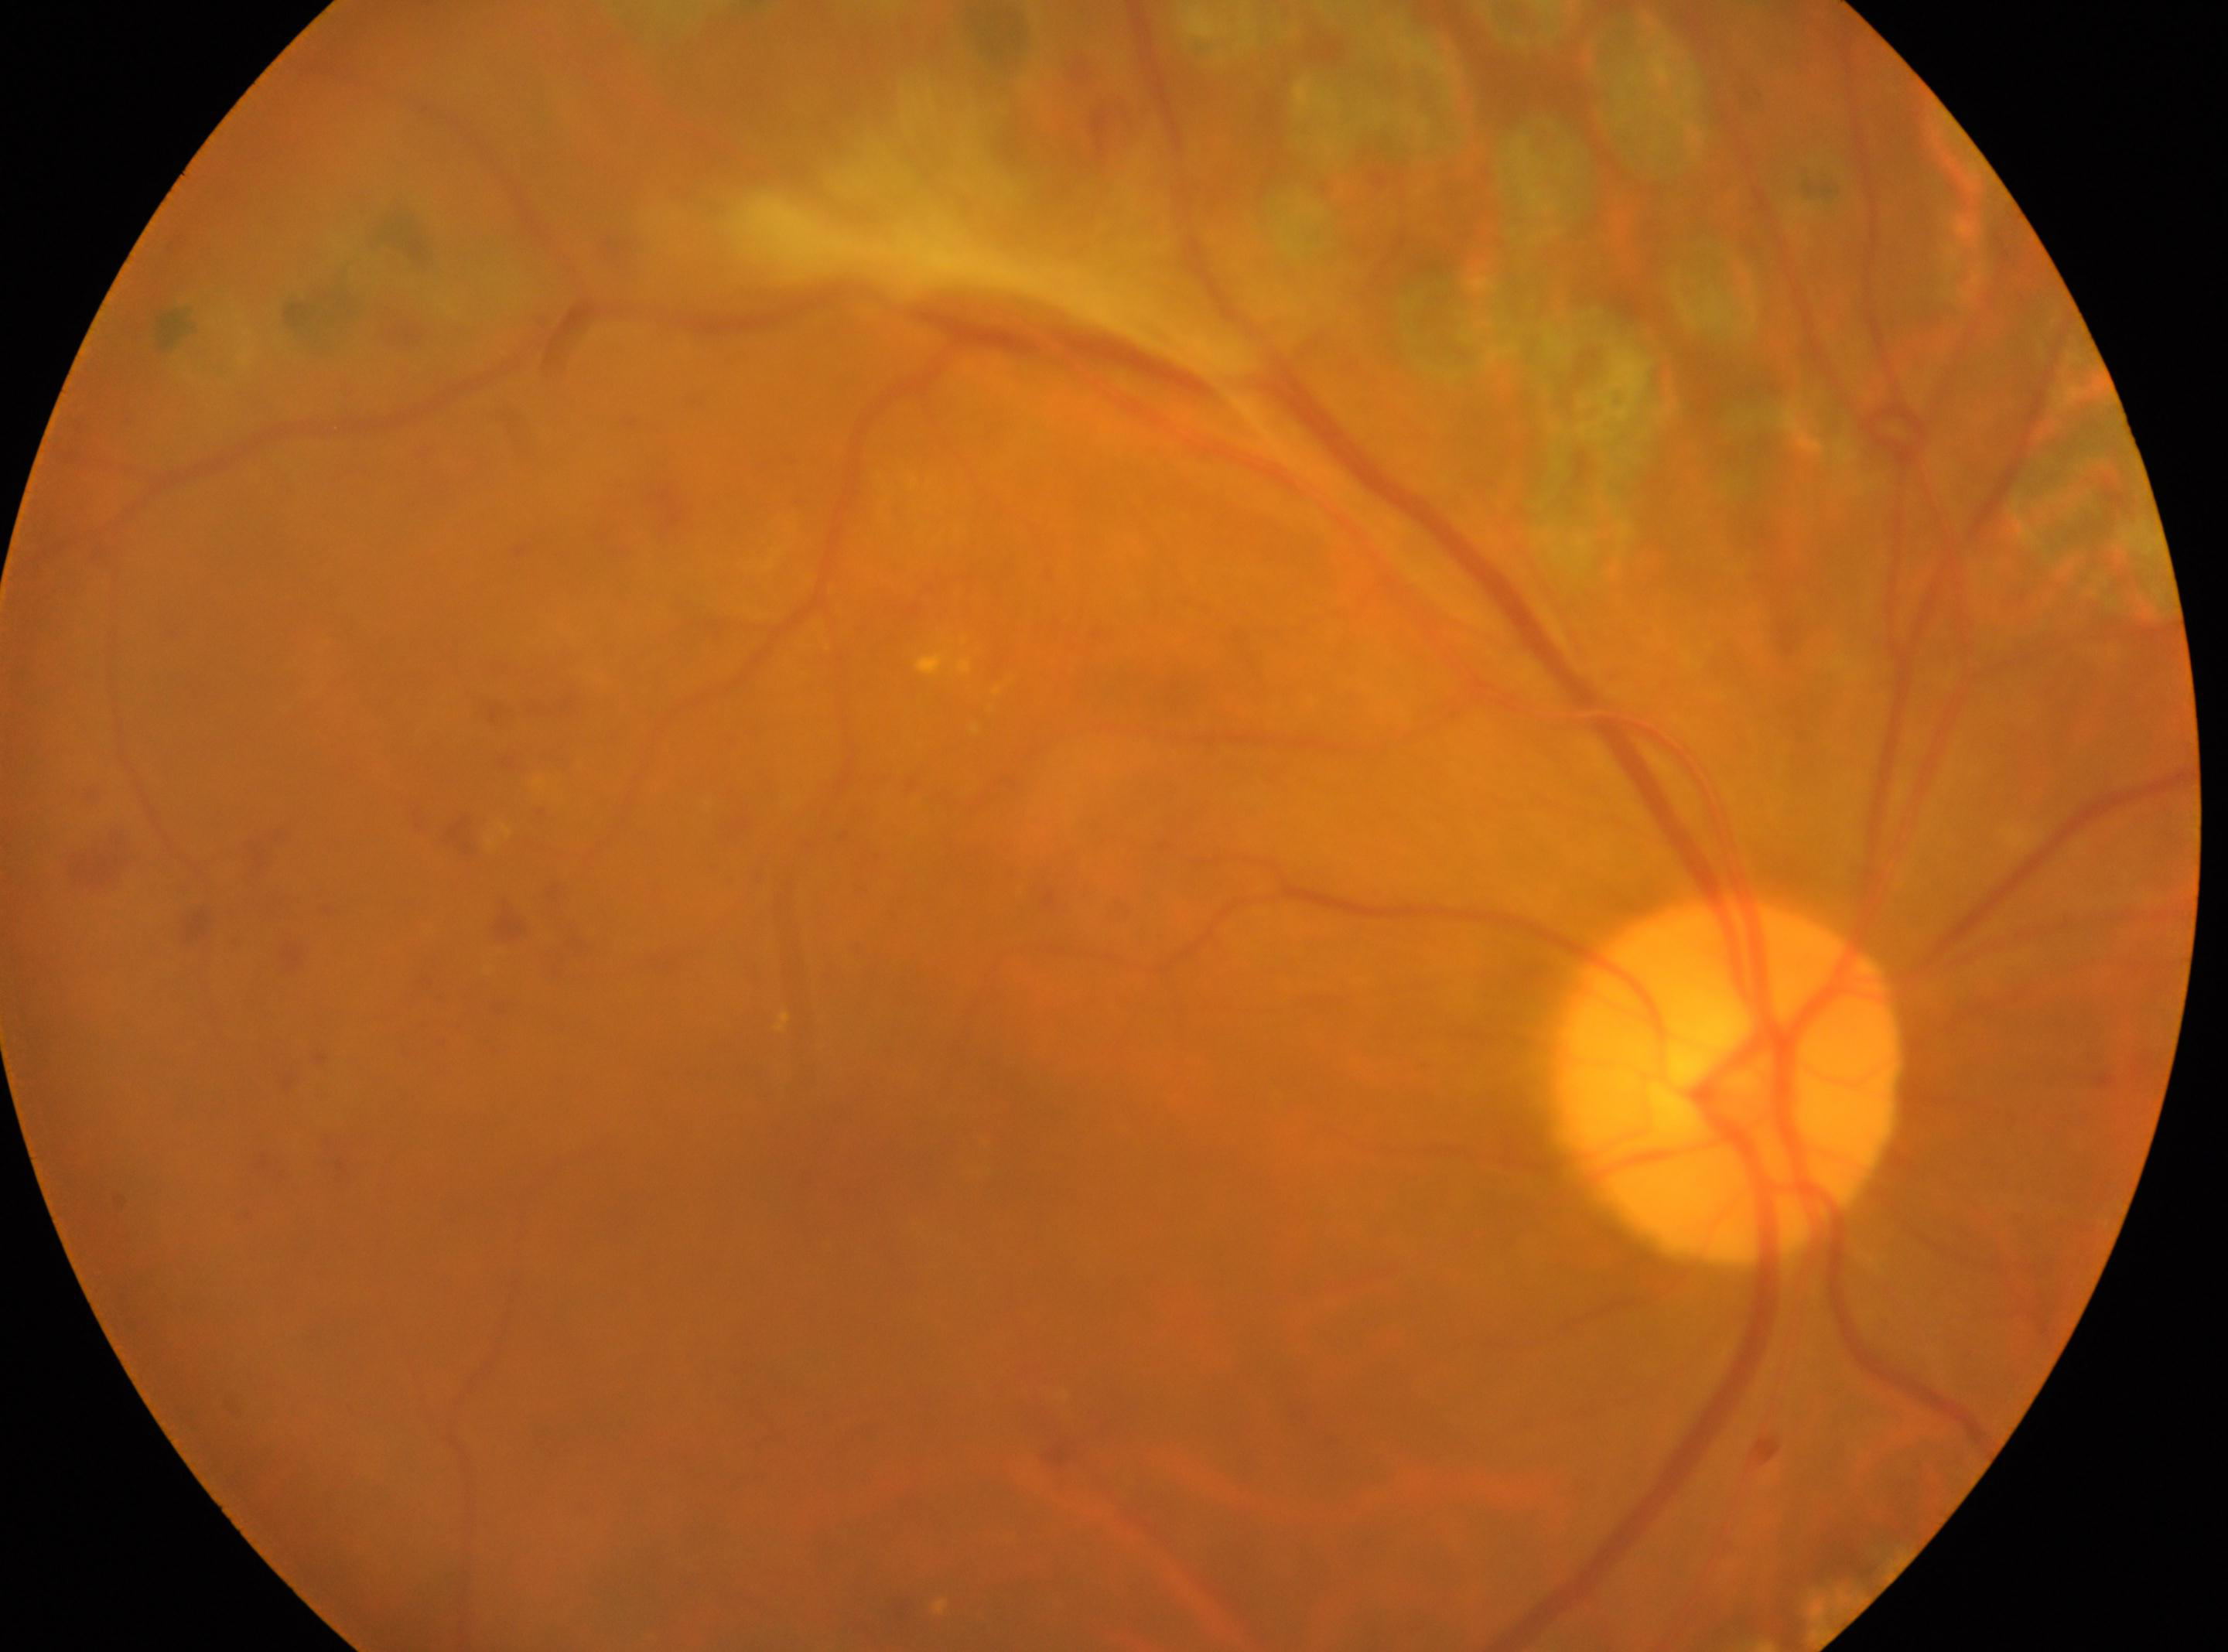
Eye: right. Diabetic retinopathy (DR): laser-treated DR, underlying severity grade 4 (PDR). Fovea center located at (x: 842, y: 1142). The optic nerve head is at (x: 1730, y: 1080).